2089 by 1764 pixels; color fundus image: 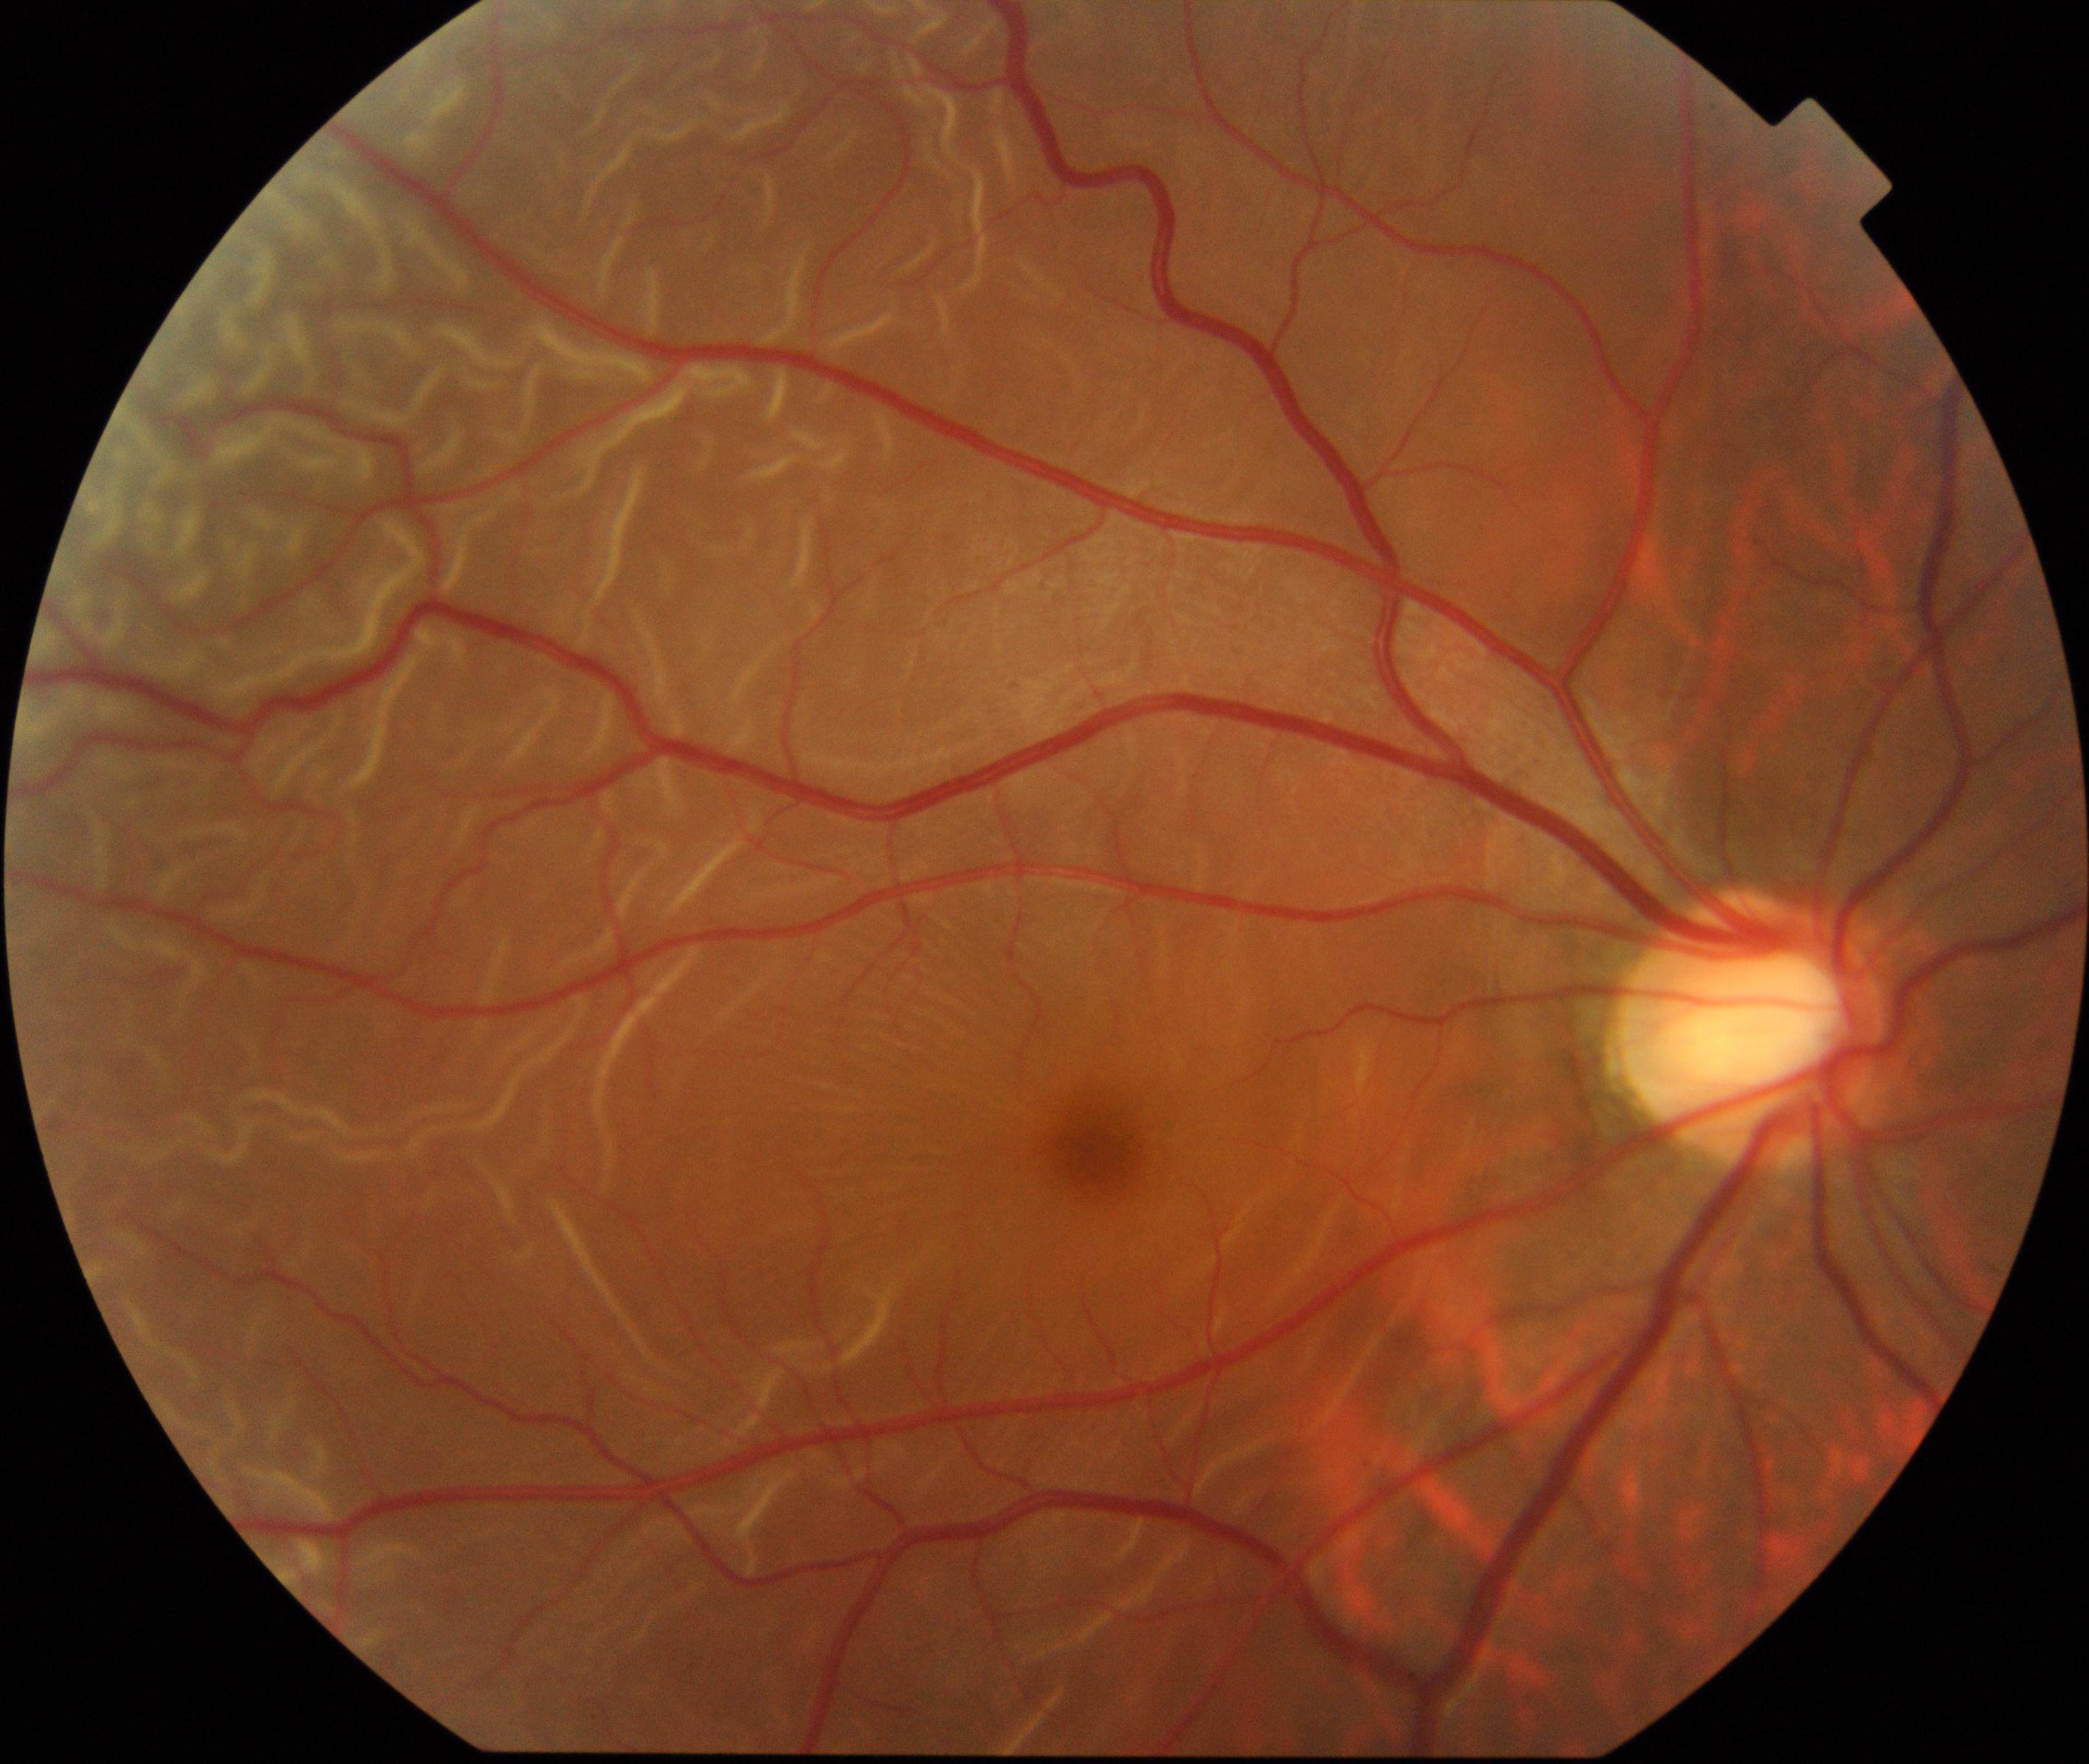

There is evidence of rhegmatogenous retinal detachment.